Color fundus photograph. Non-mydriatic acquisition:
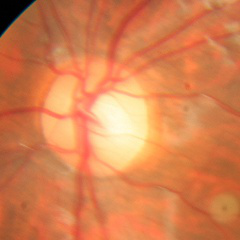

No signs of glaucoma.